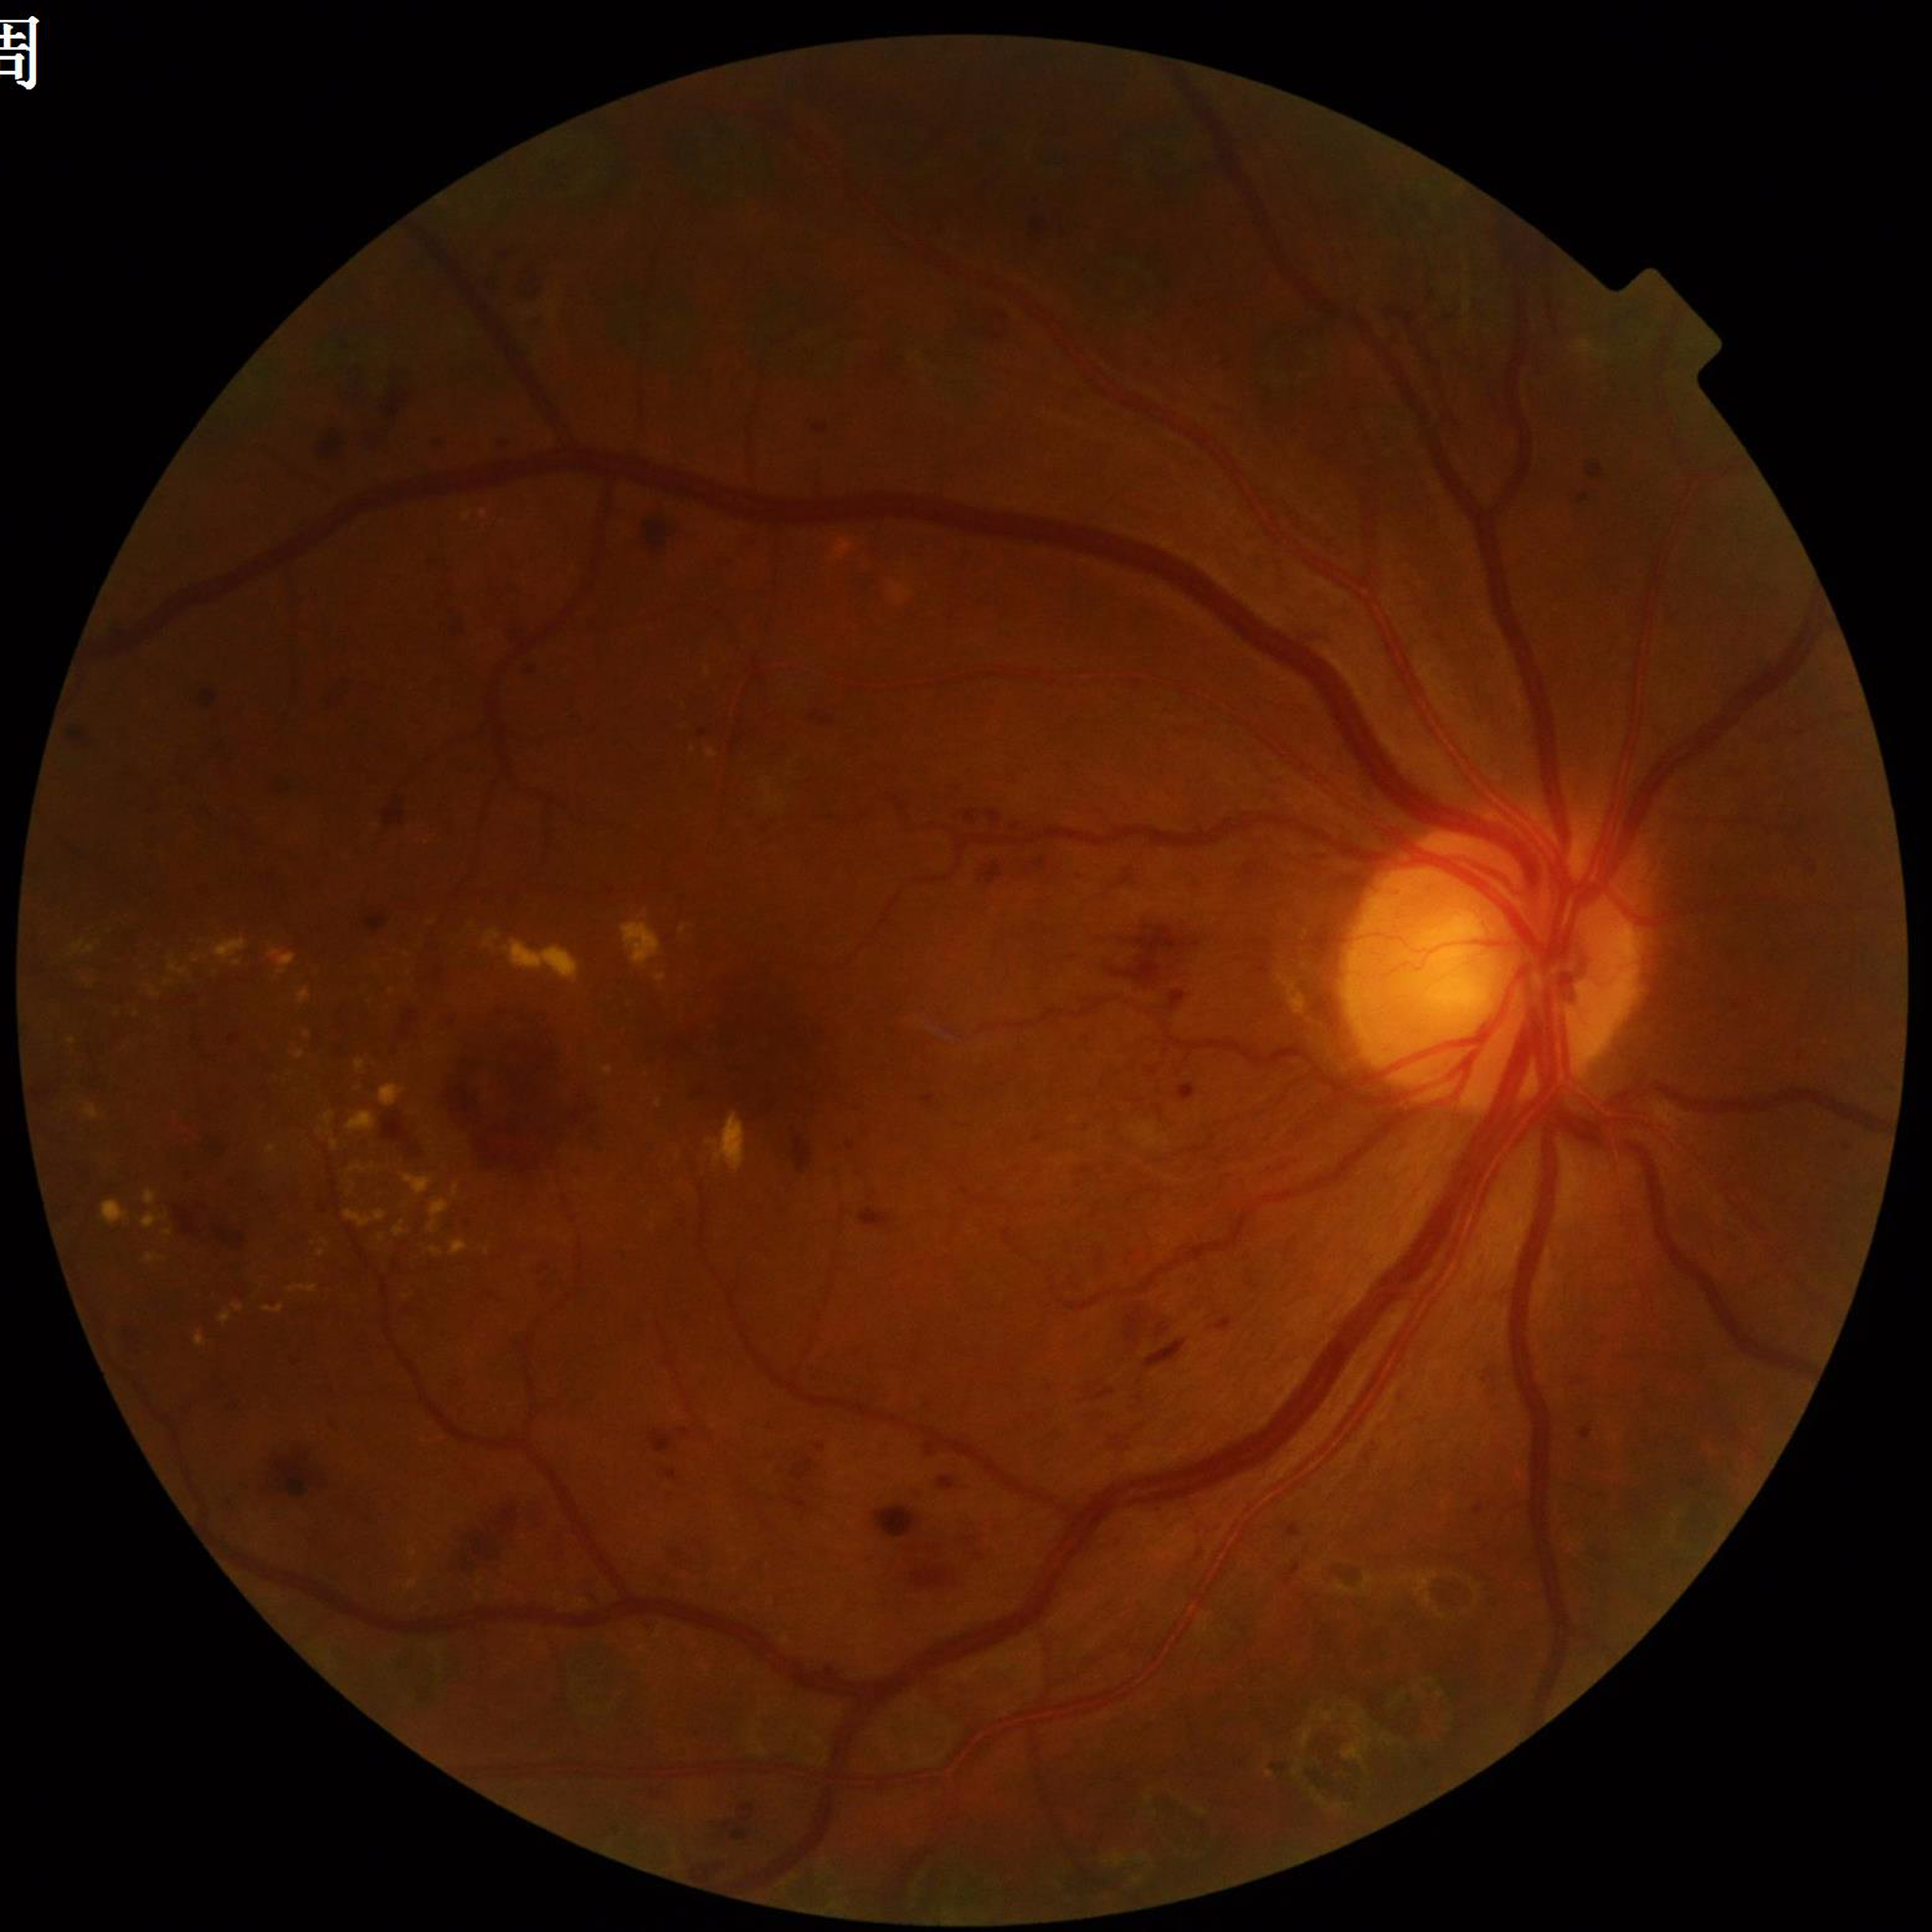 Clinical diagnosis: diabetic retinopathy
Automated quality assessment: satisfactory